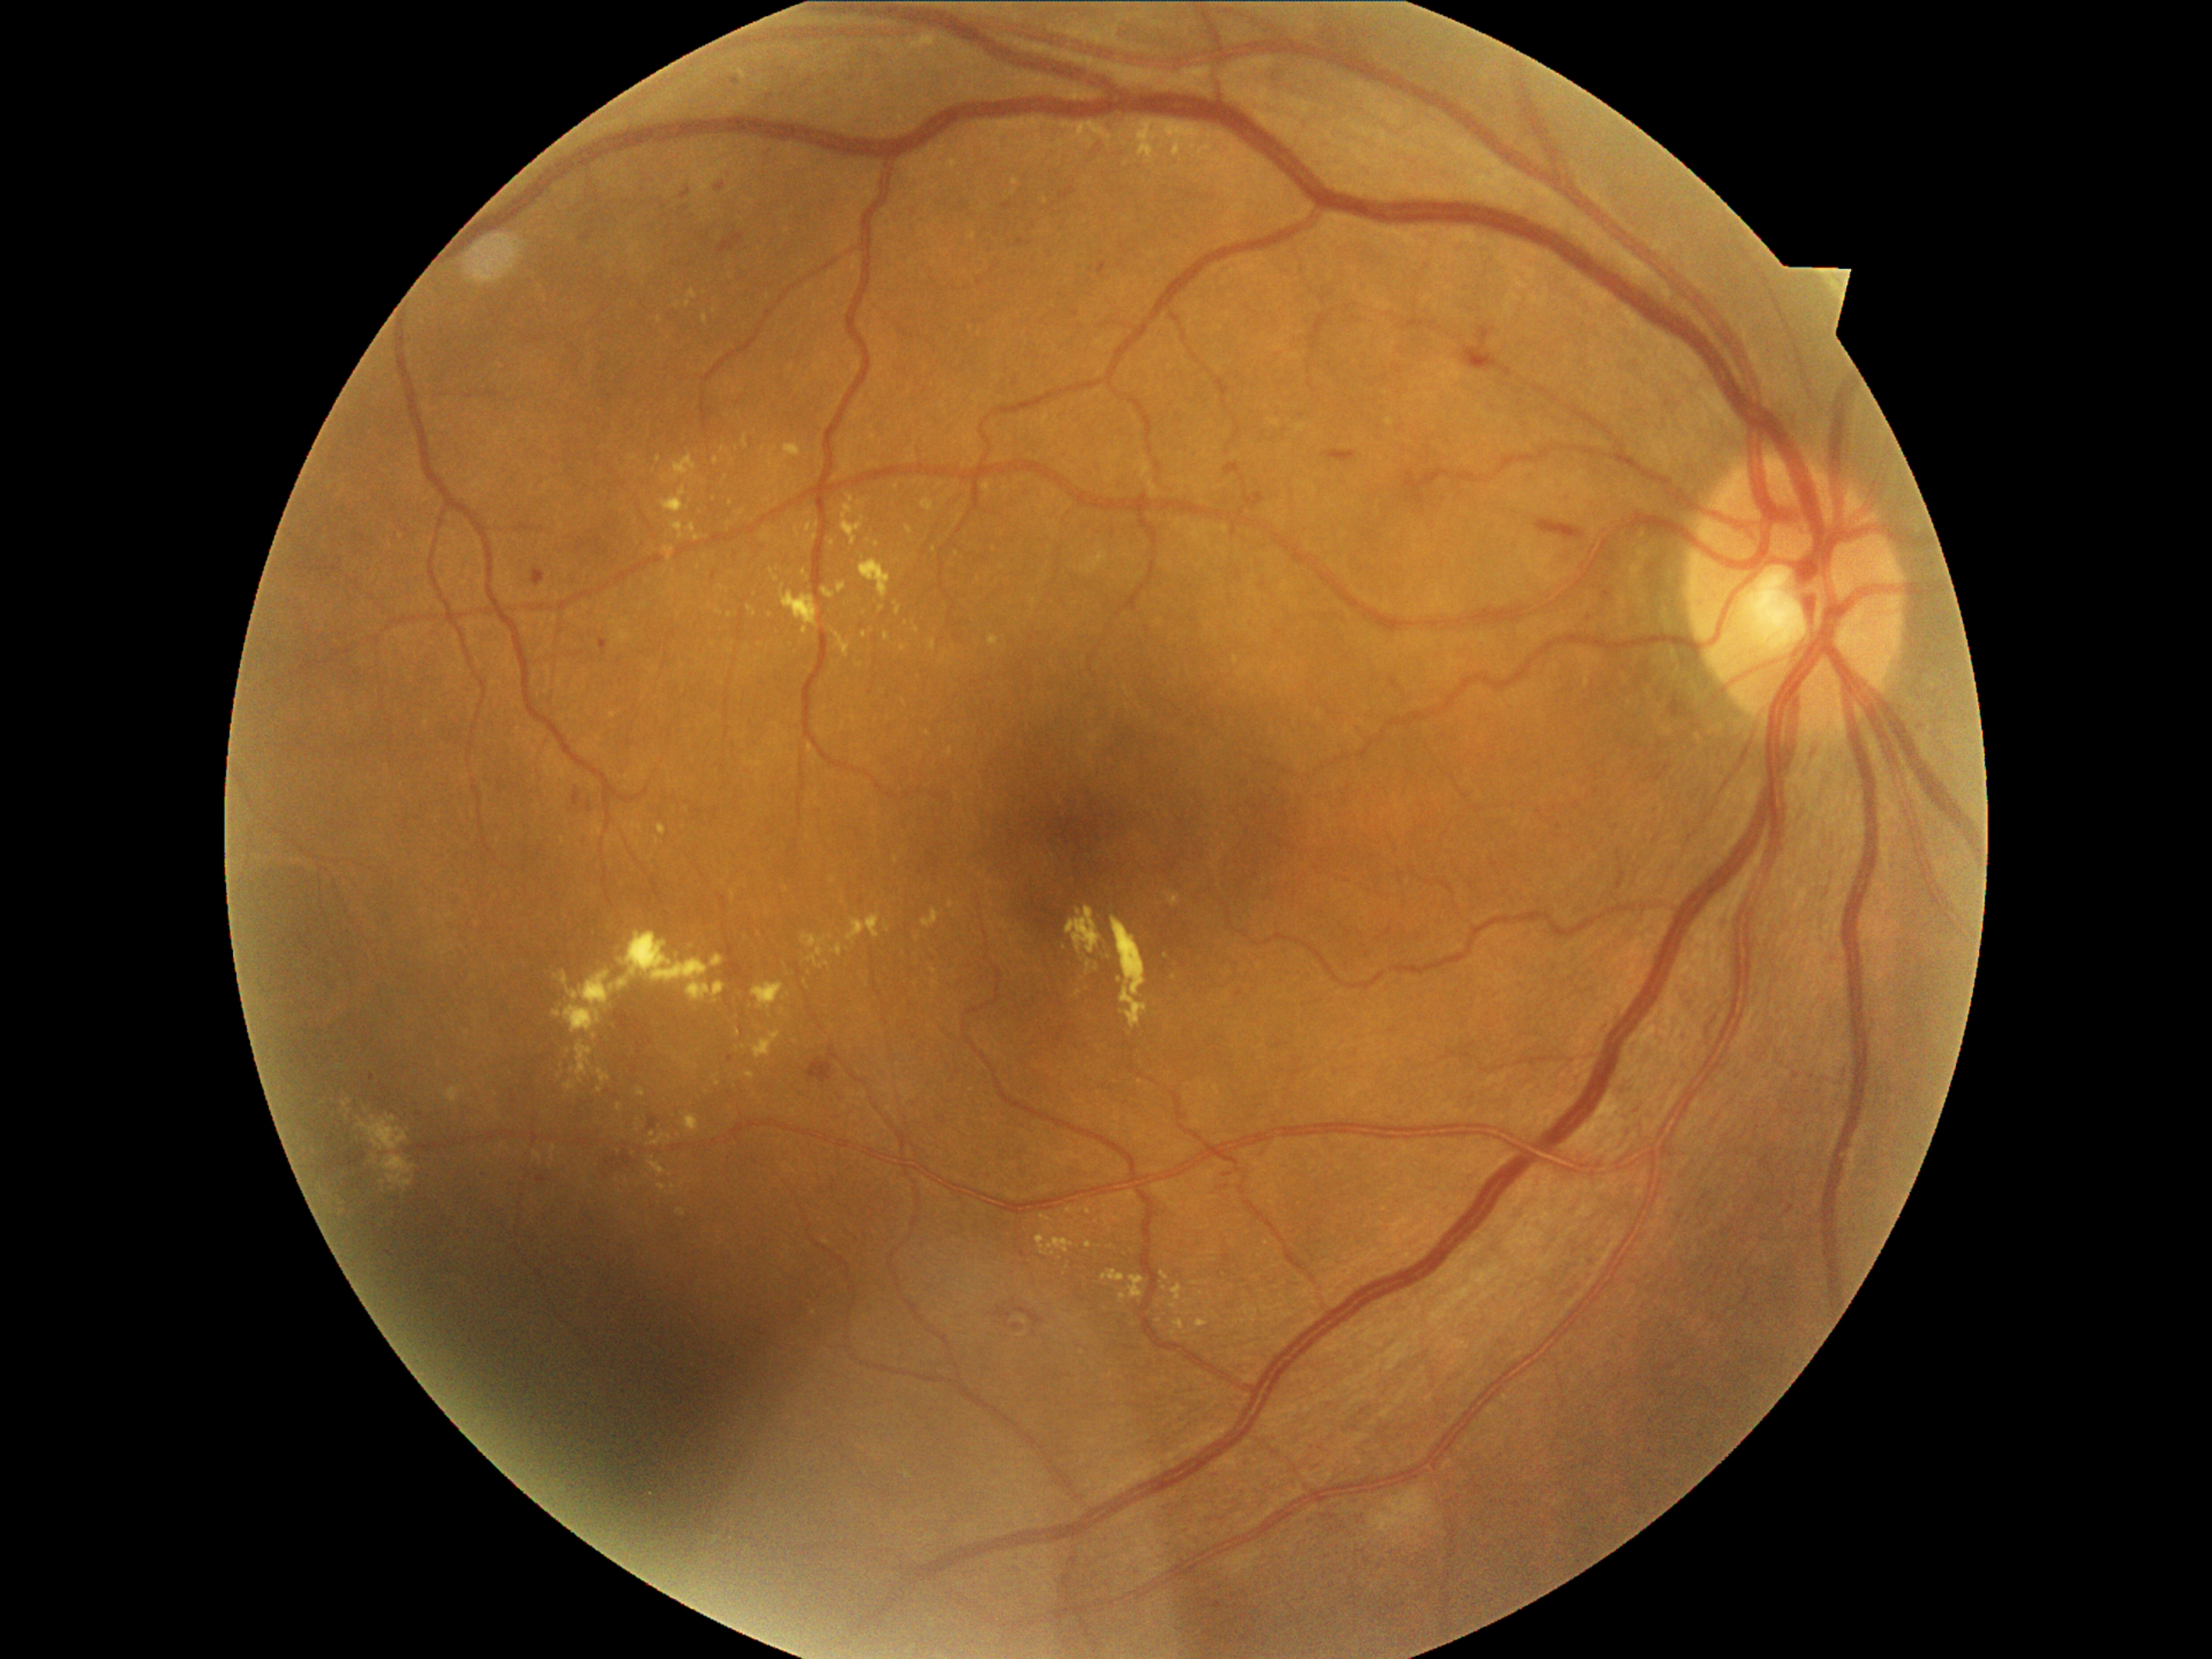 <lesions partial="true">
  <dr_grade>2</dr_grade>
  <ex partial="true">1172,1286,1184,1301 | 834,945,842,958 | 1102,1271,1126,1283 | 672,457,697,484 | 1175,1320,1185,1330 | 779,585,820,636 | 883,632,890,641 | 929,639,936,651 | 847,914,882,945 | 806,523,813,533 | 1170,1305,1179,1310</ex>
  <ex_small>(865; 635) | (594; 1036) | (877; 544) | (688; 304) | (557; 979) | (659; 460) | (726; 478) | (1175; 979)</ex_small>
</lesions>